Nonmydriatic · 848x848px.
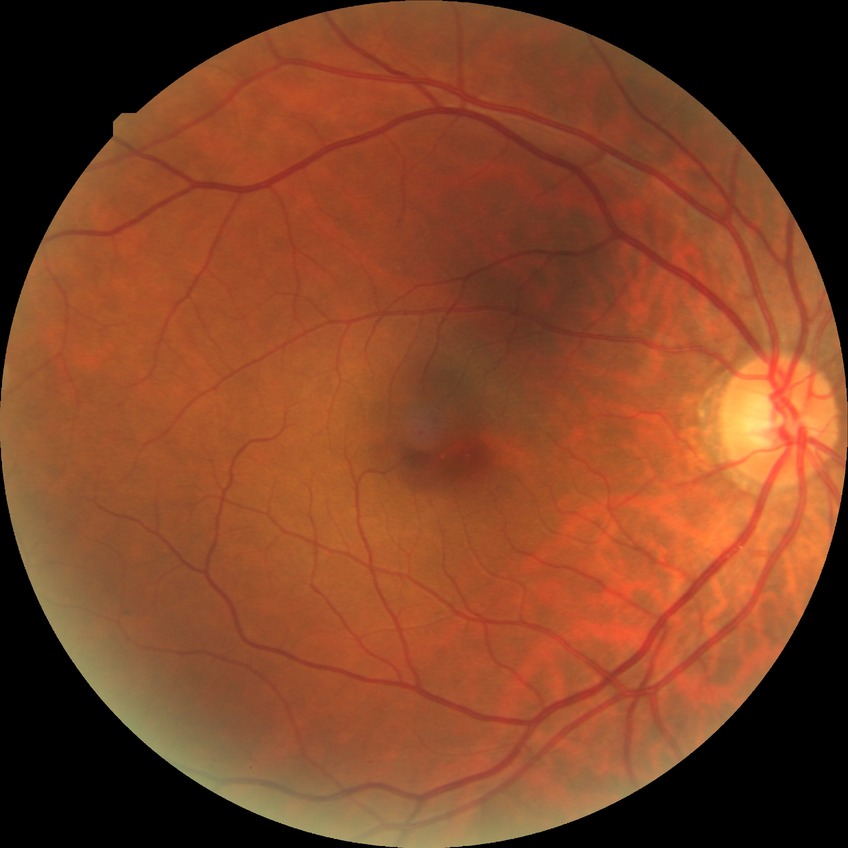

  davis_grade: simple diabetic retinopathy